Color fundus image
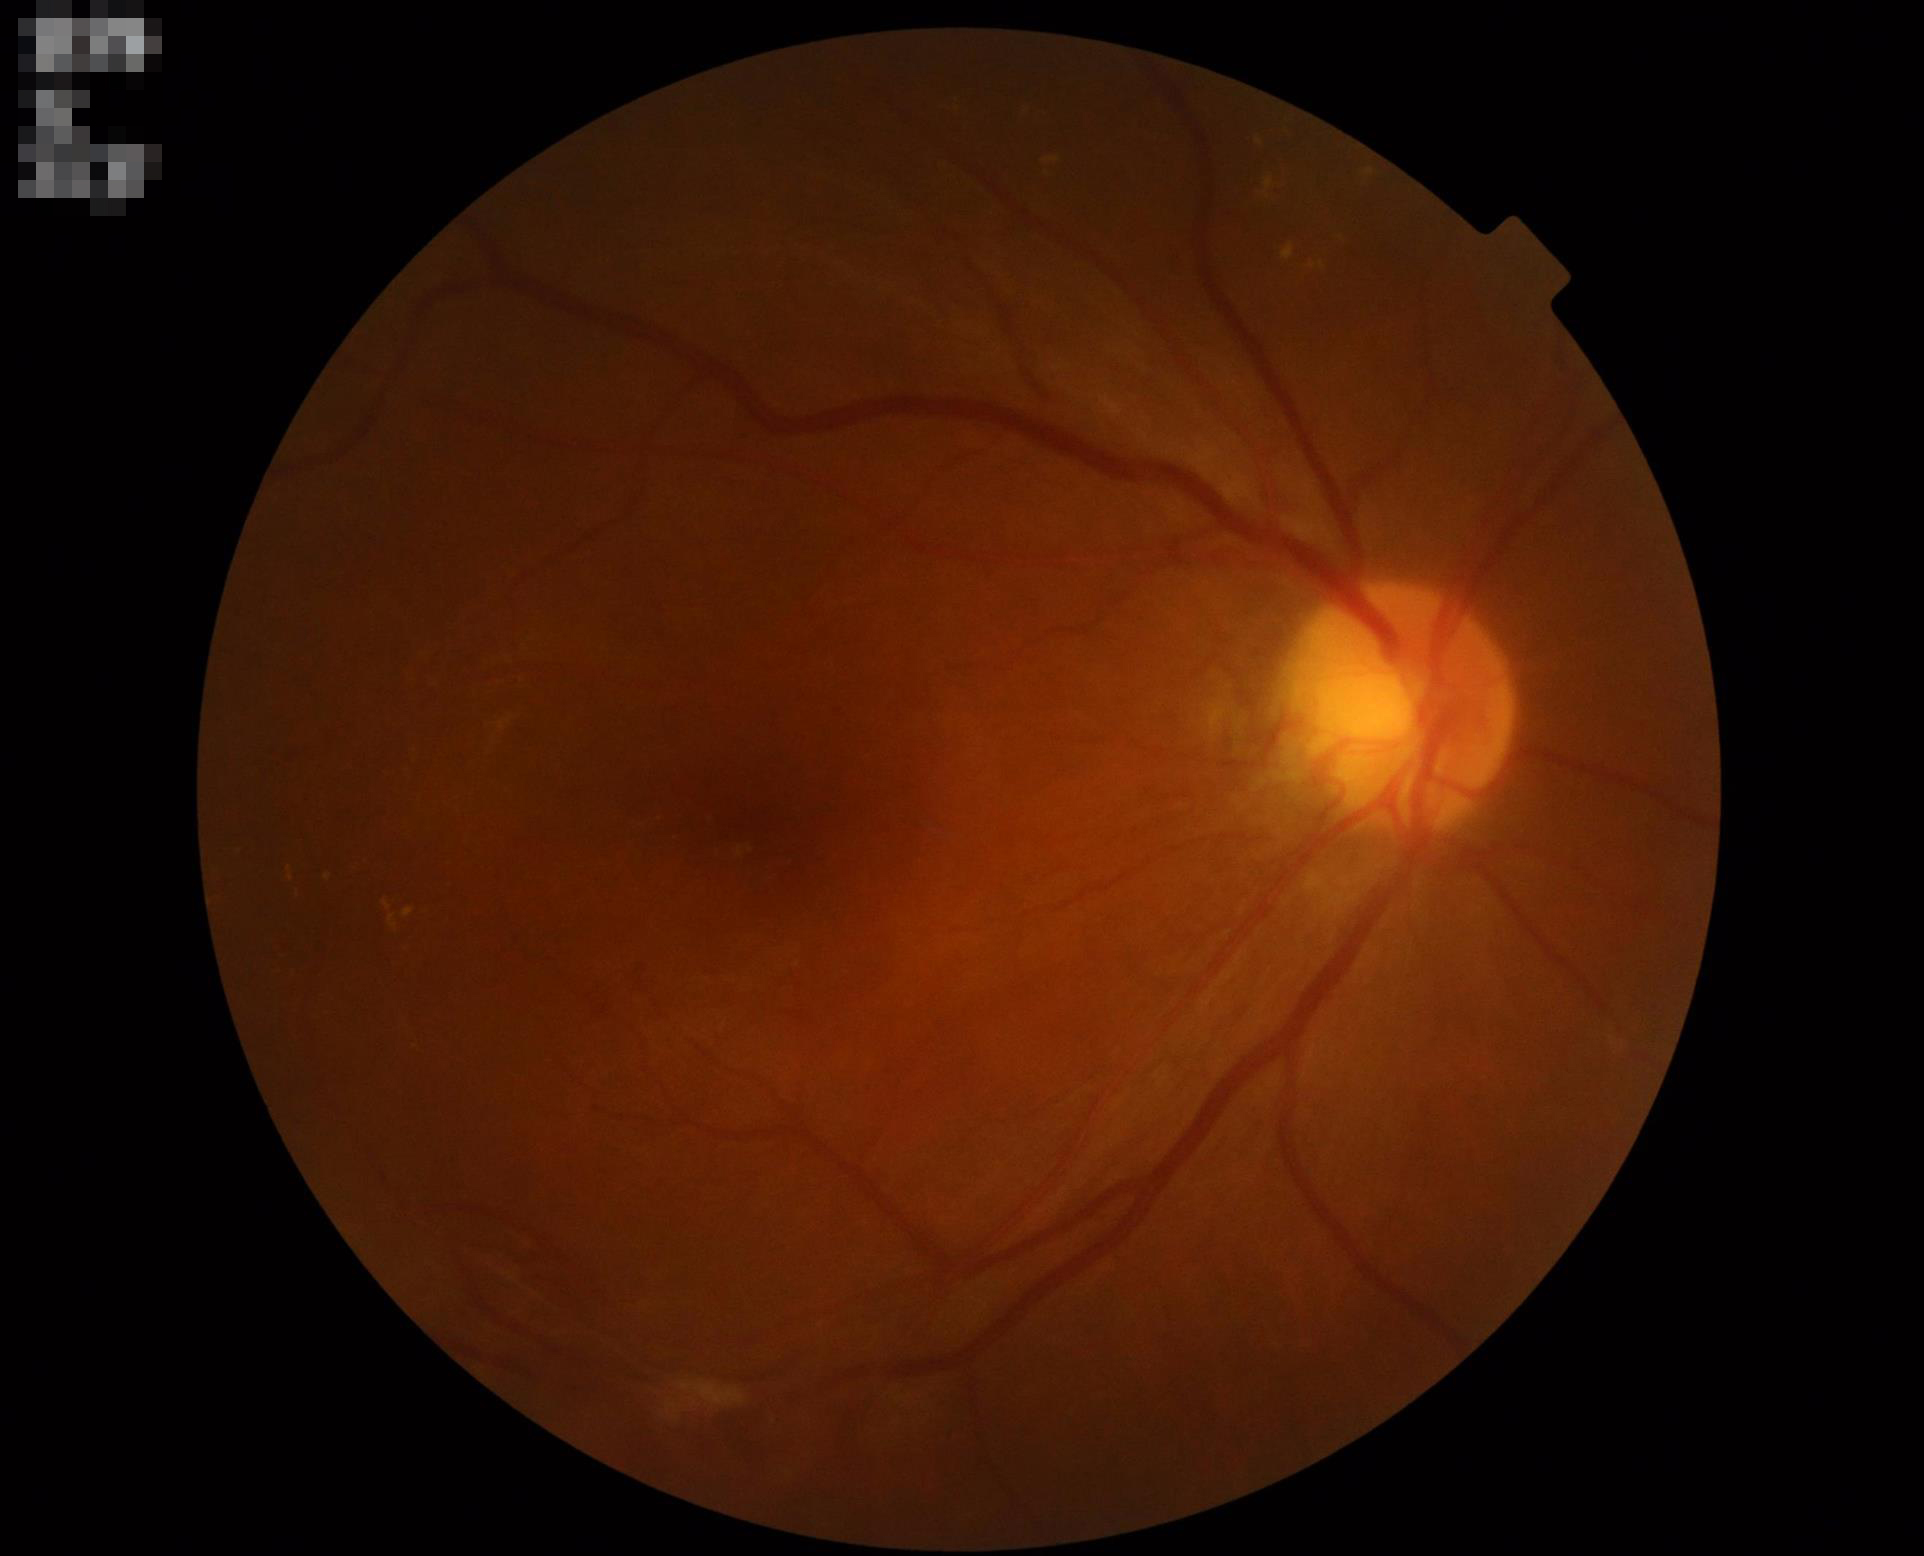 No noticeable blur.
Overall quality is good and the image is gradable.
Illumination is even.
Good dynamic range.